Ultra-widefield fundus mosaic — 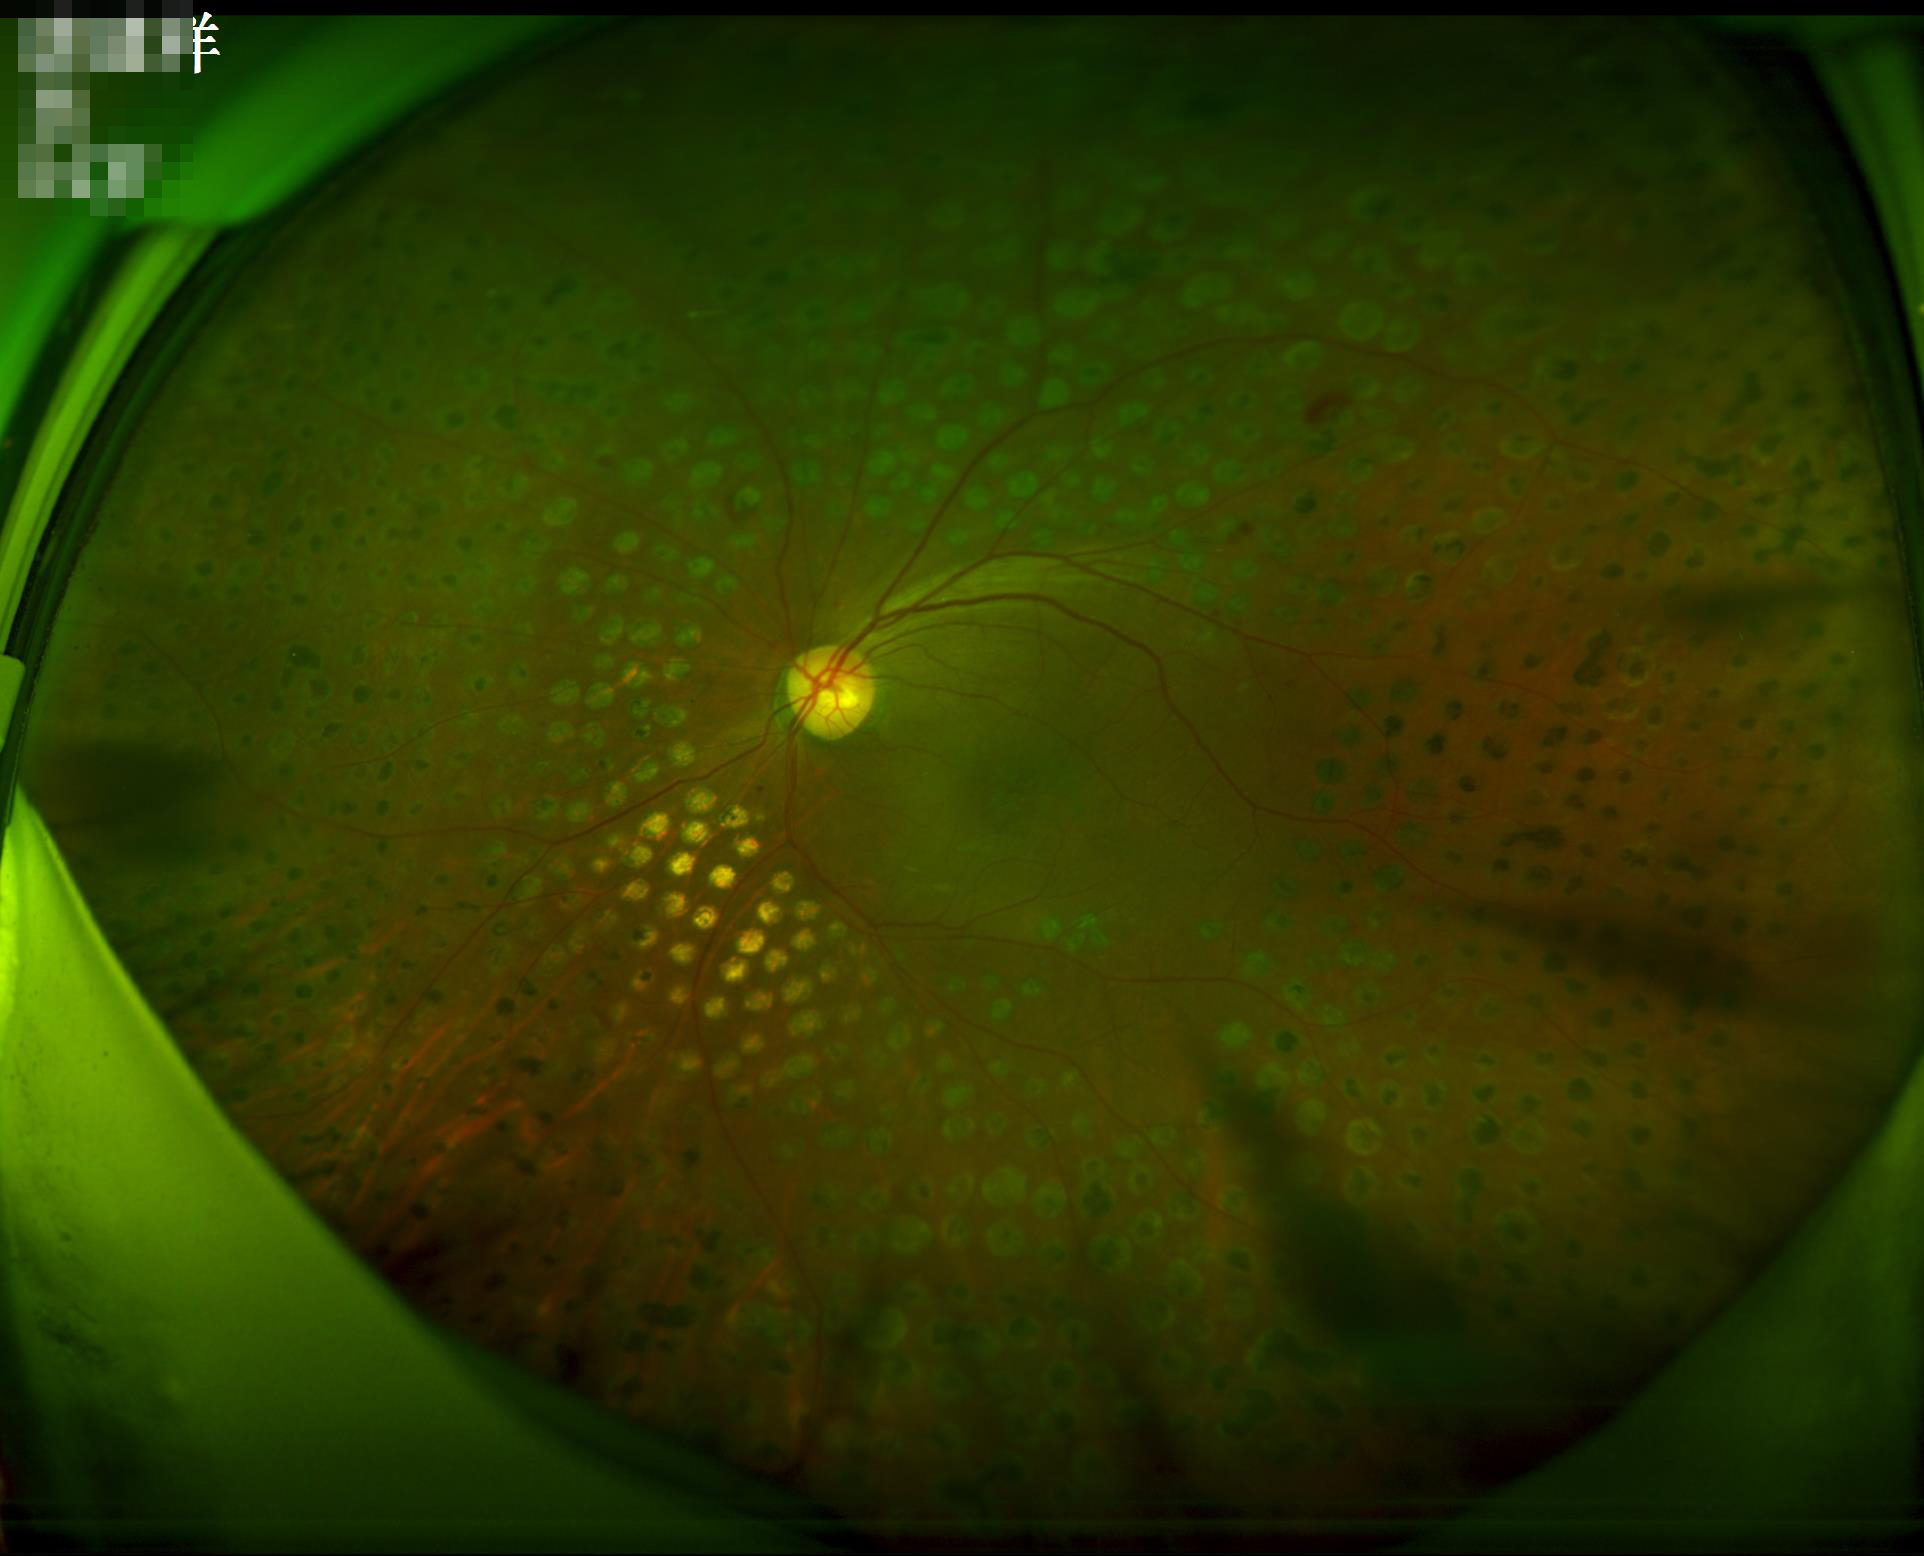

Contrast: wide intensity range, structures distinguishable; Illumination: no over- or under-exposure.